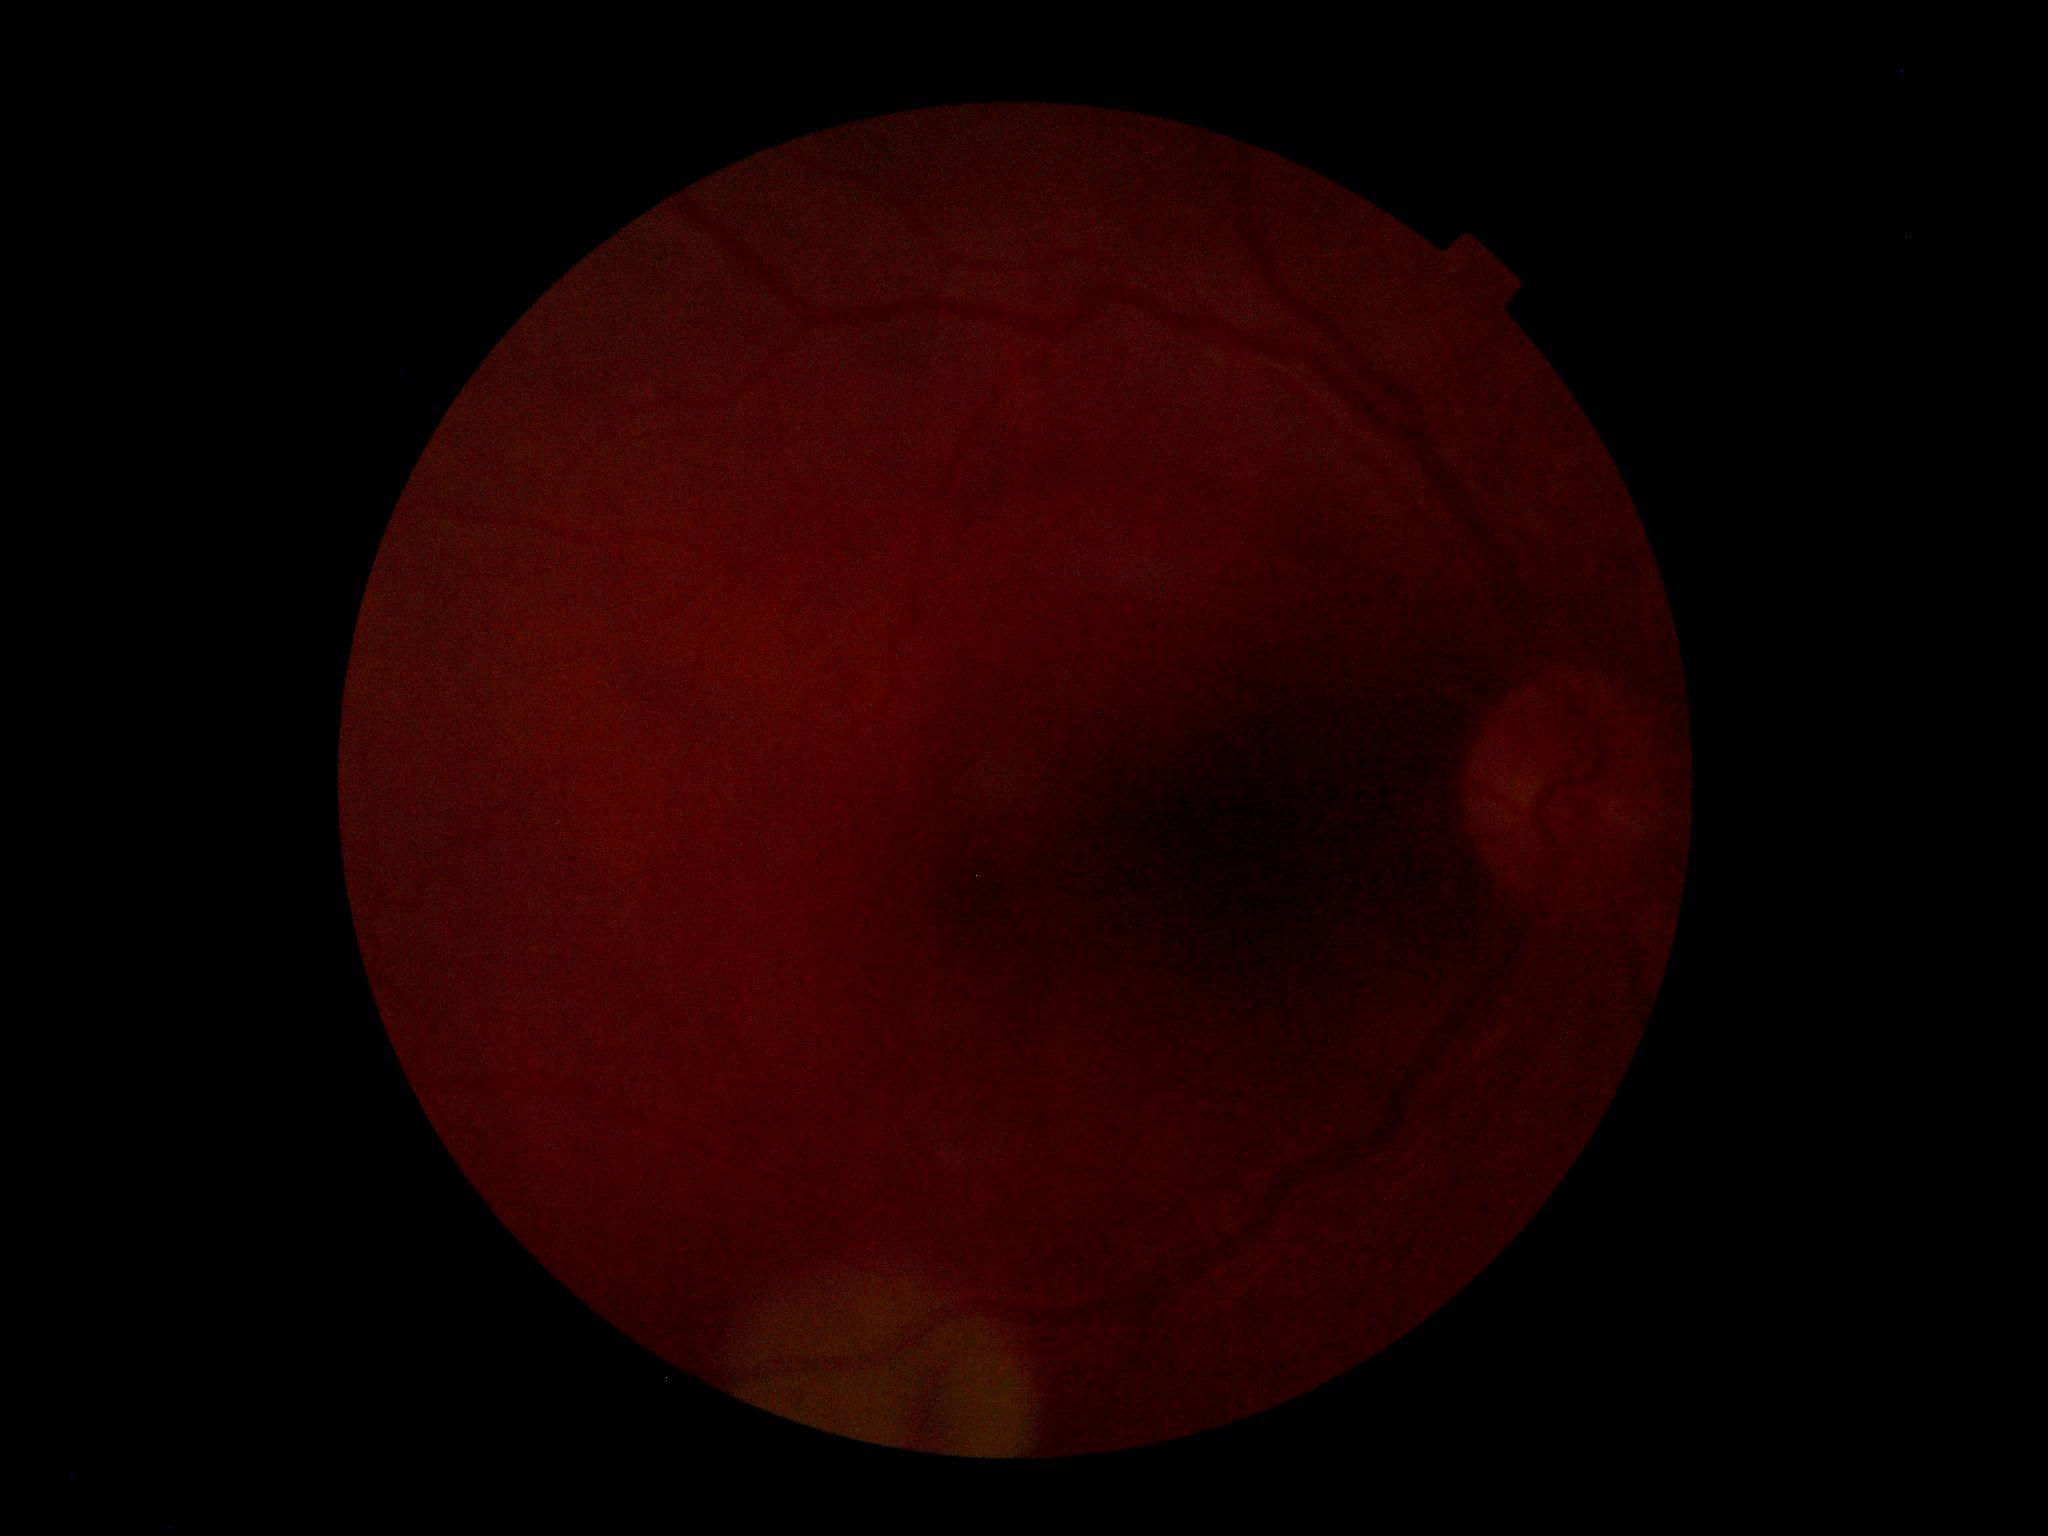
Findings:
* DR stage: ungradable due to poor image quality
* image quality: too poor for DR grading